2228x1652; 50° FOV; fundus photo; dilated-pupil acquisition — 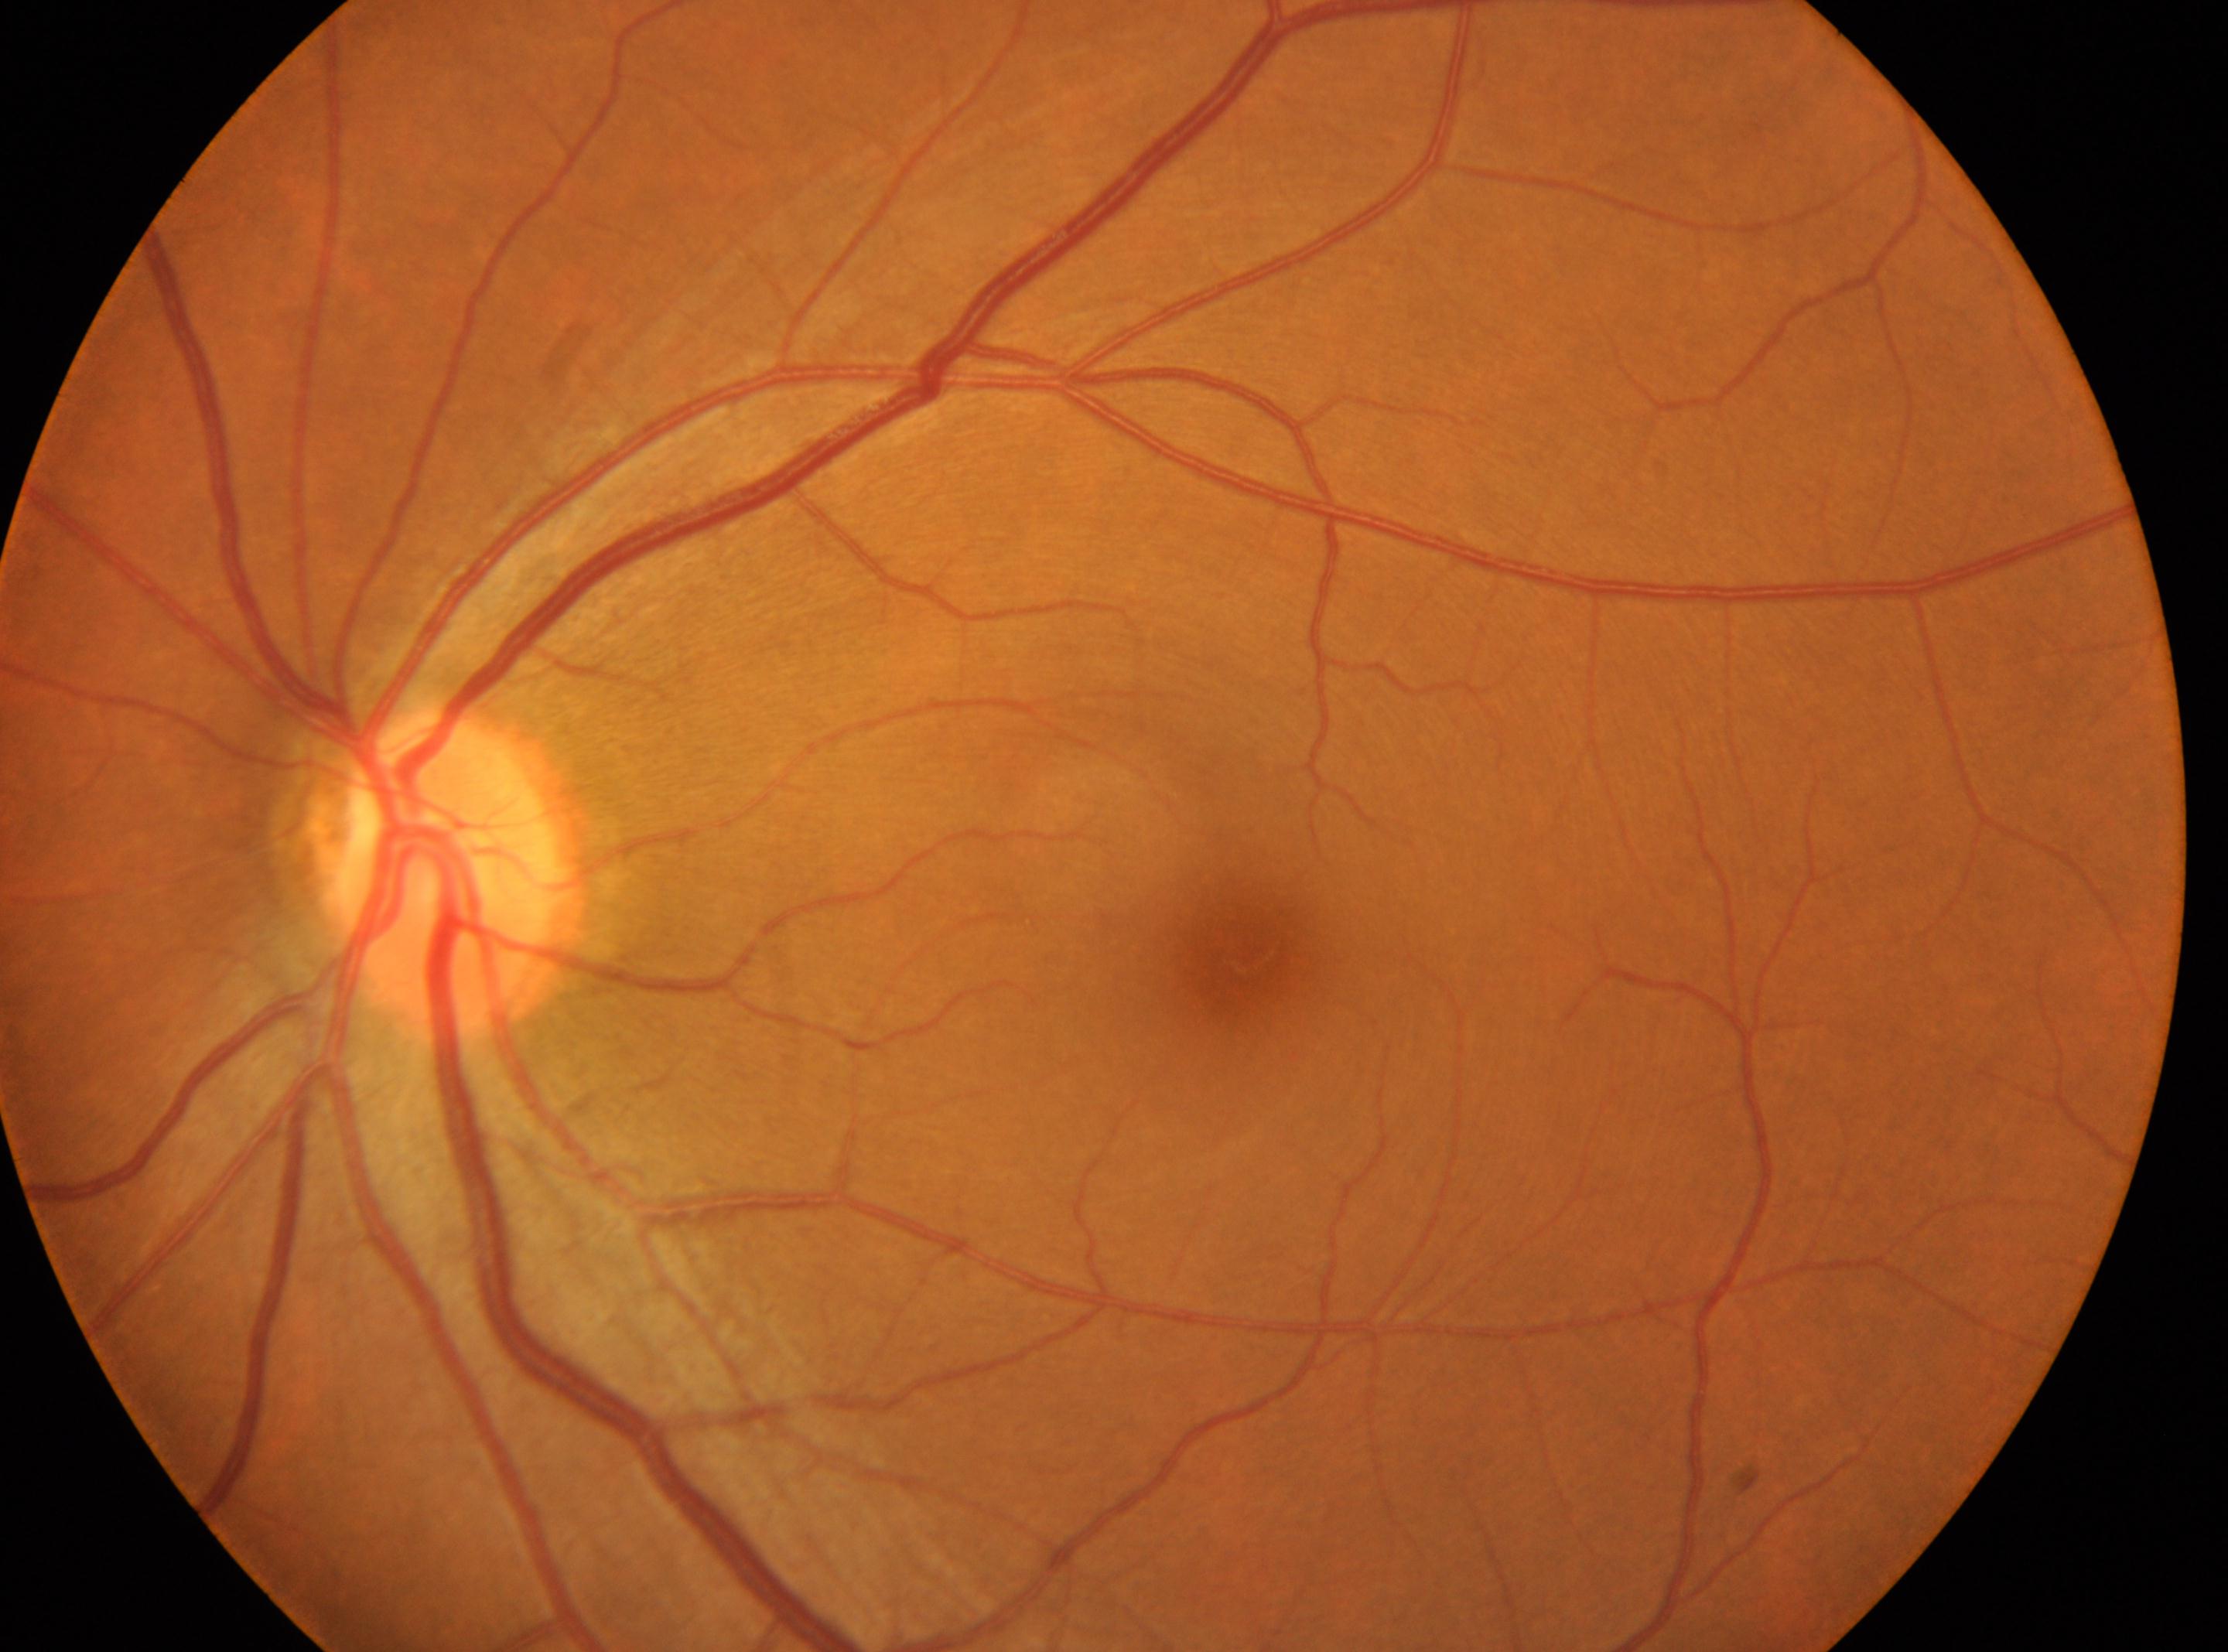
Retinopathy grade: 0.
The ONH is at x=438, y=873.
Fovea centralis located at x=1242, y=957.
The image shows the left eye.